FOV: 45 degrees — 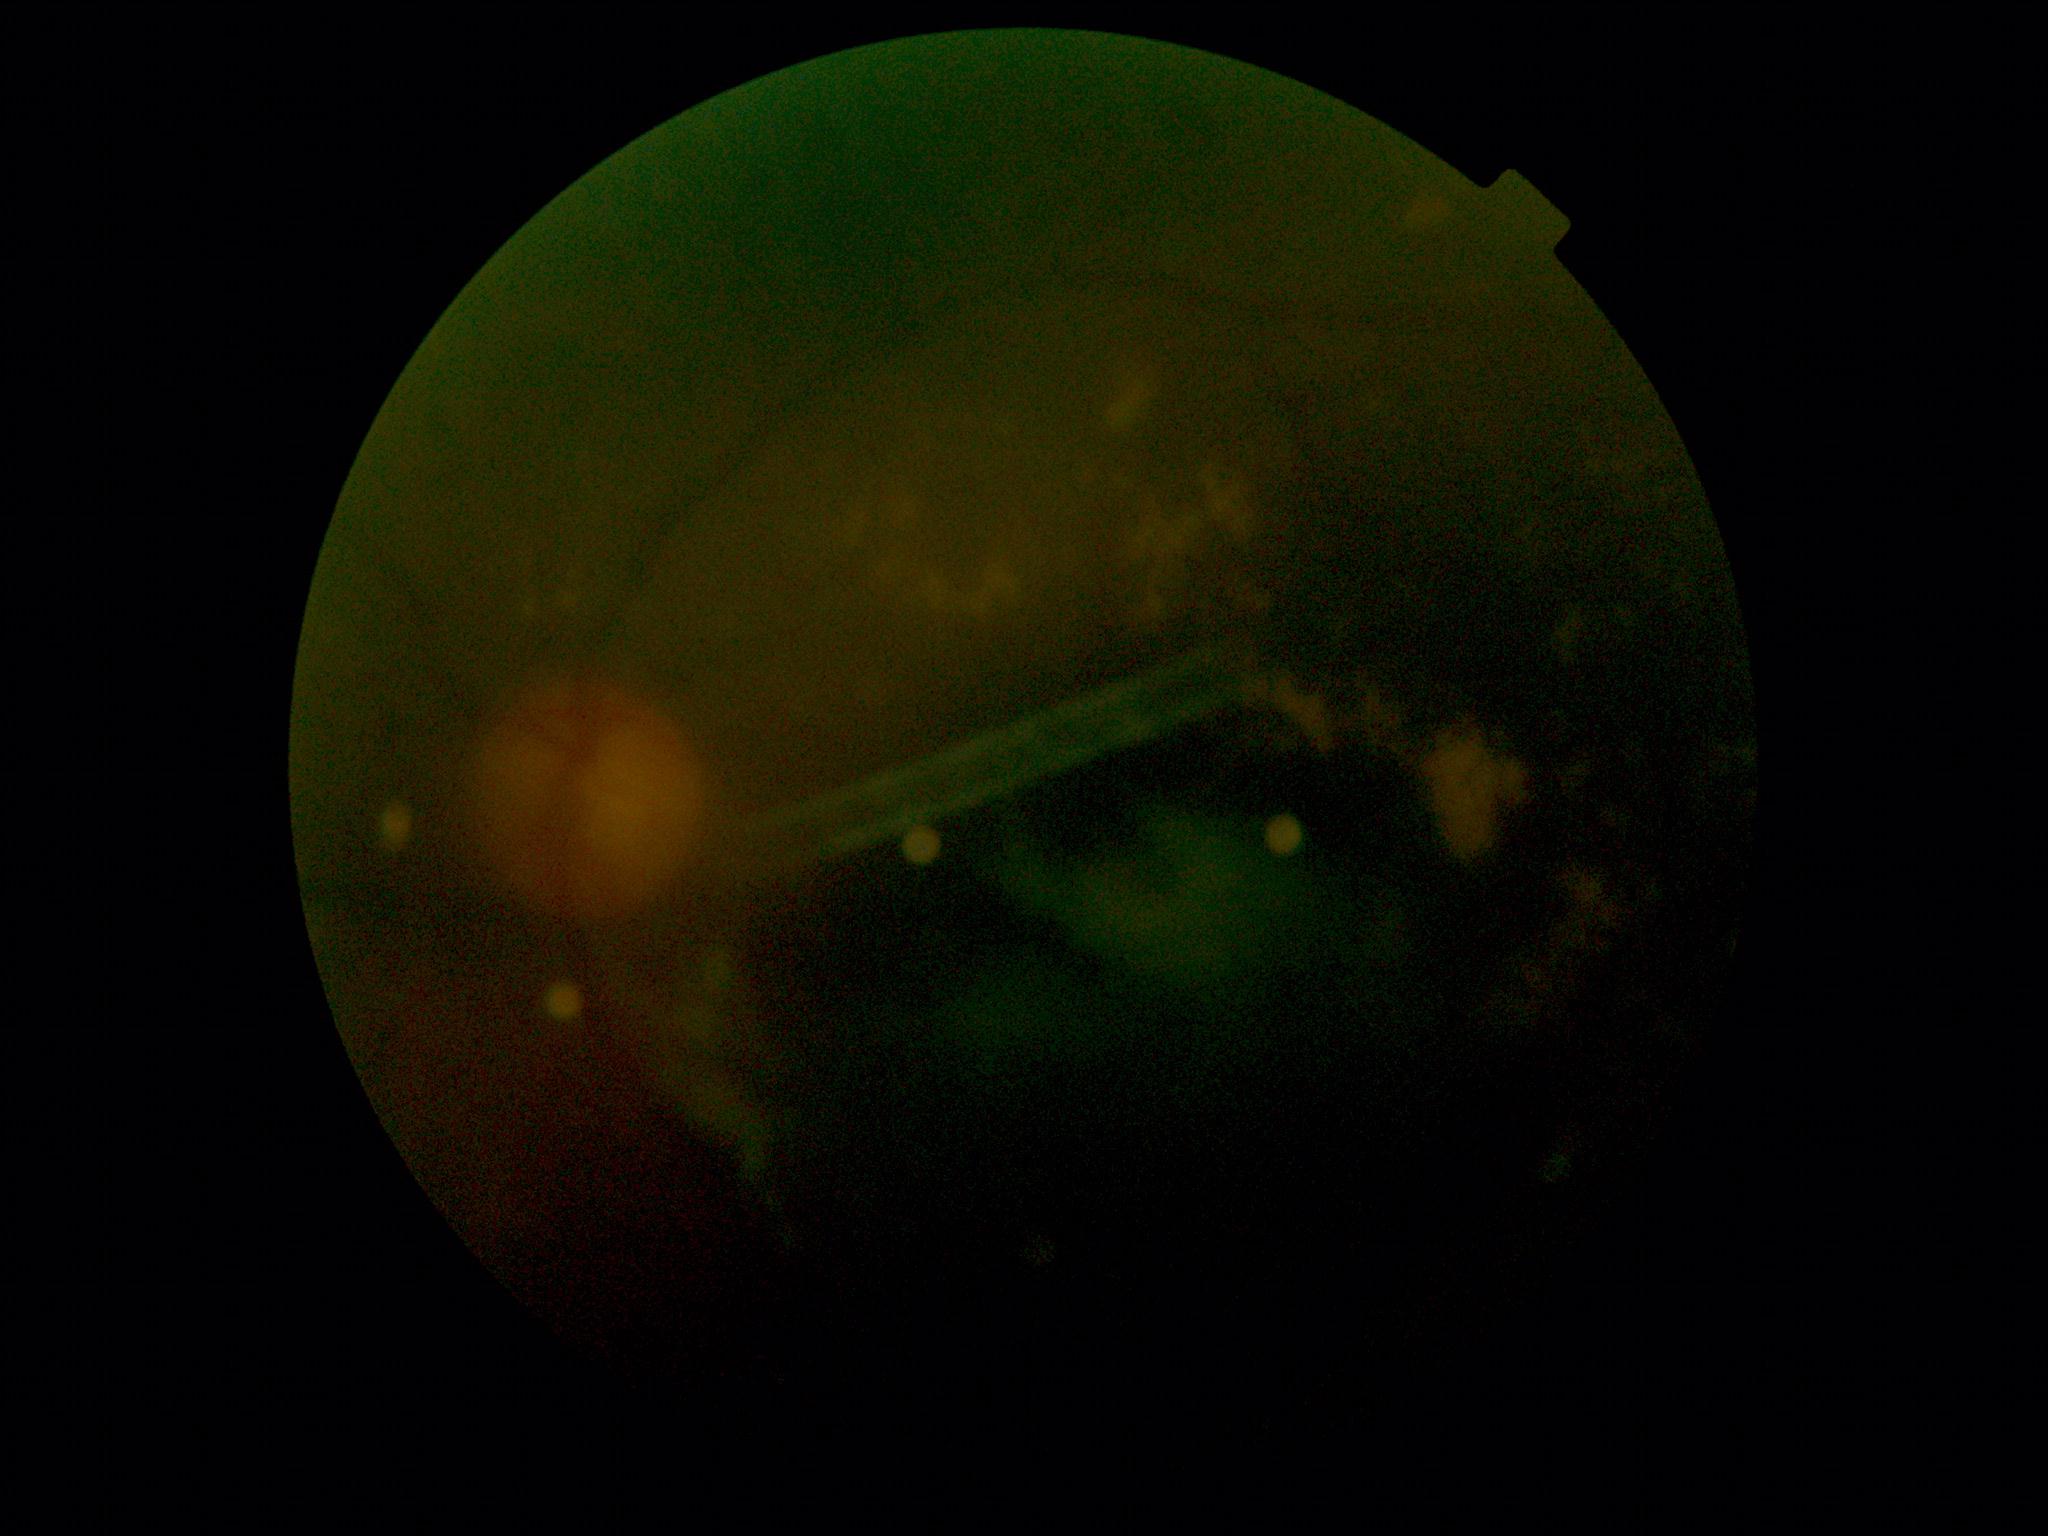
{
  "dr_grade": "moderate NPDR (grade 2)"
}